Wide-field fundus photograph from neonatal ROP screening — 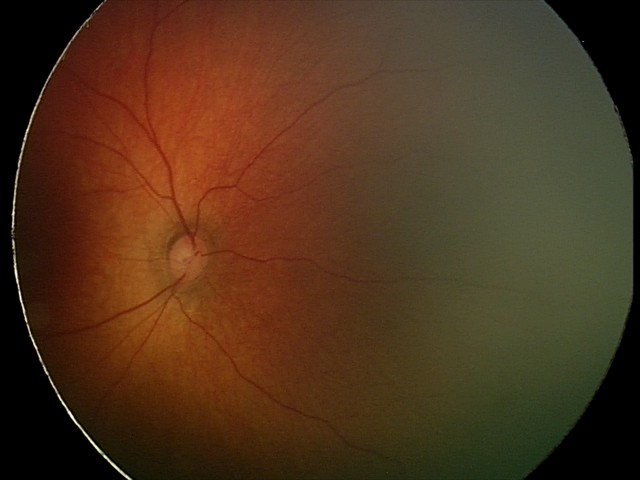
Screening examination diagnosed as physiological.